Retinal fundus photograph, image size 2352x1568, 45-degree field of view
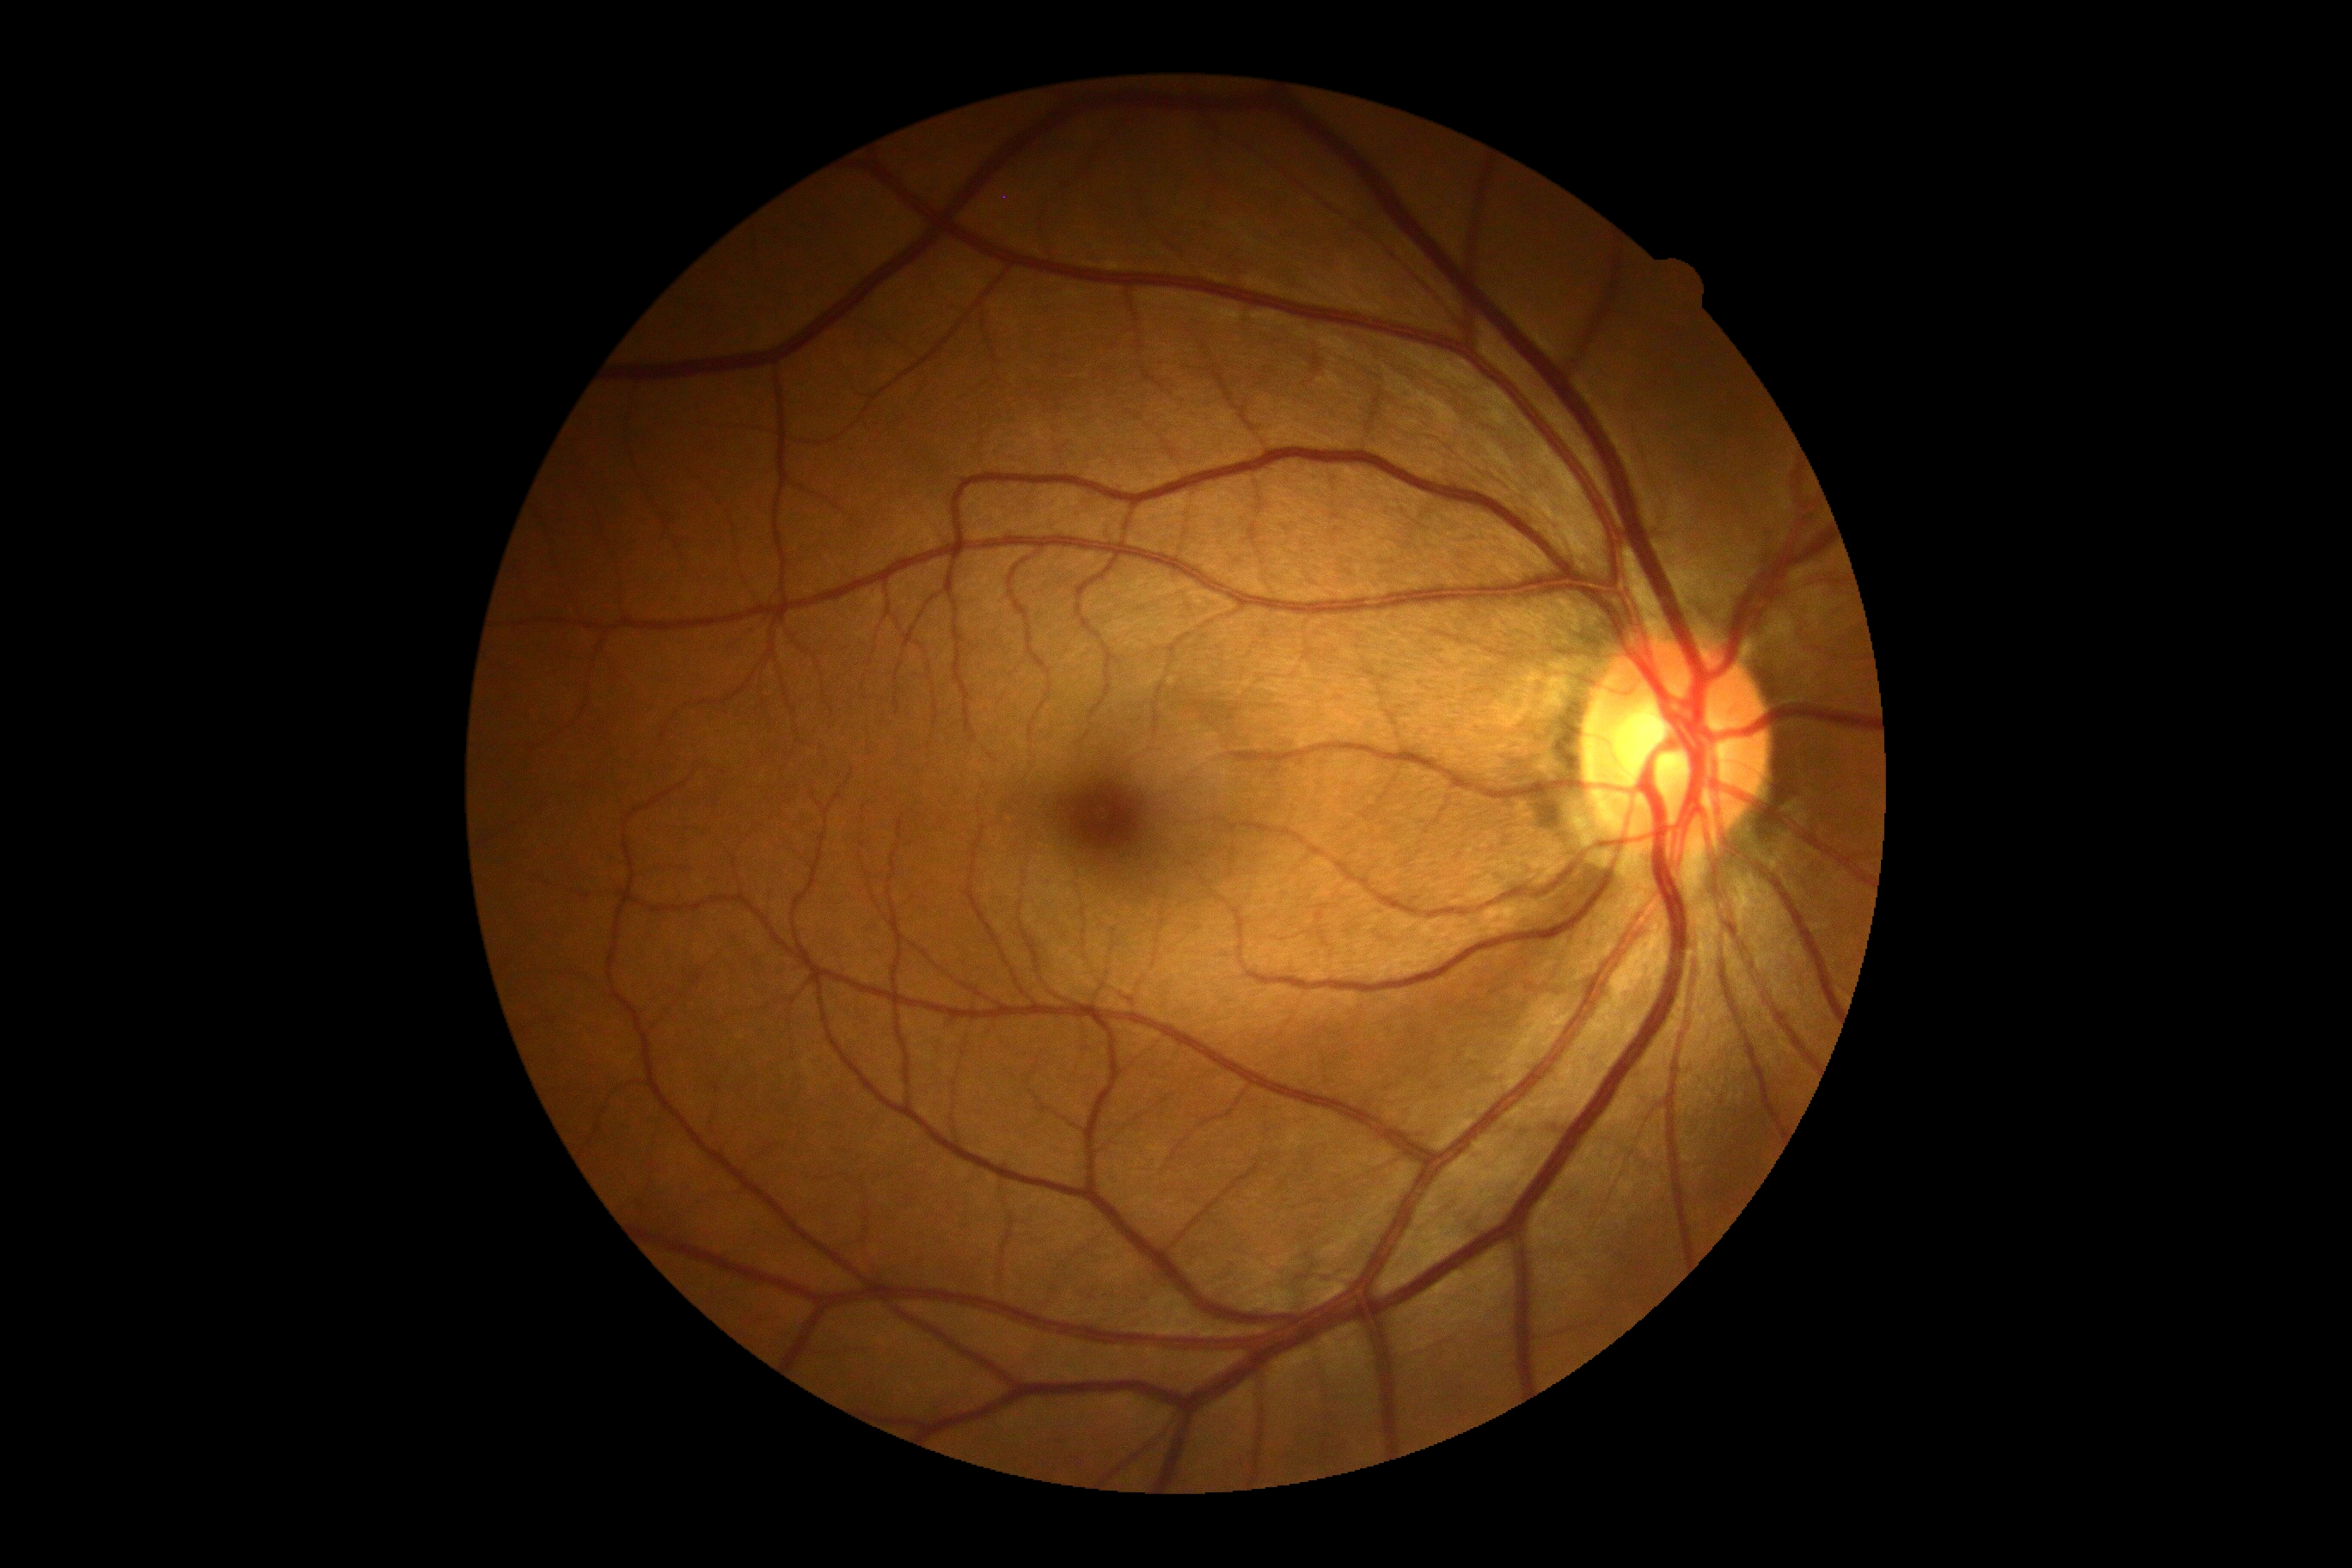 Diabetic retinopathy severity: grade 0 (no apparent retinopathy).